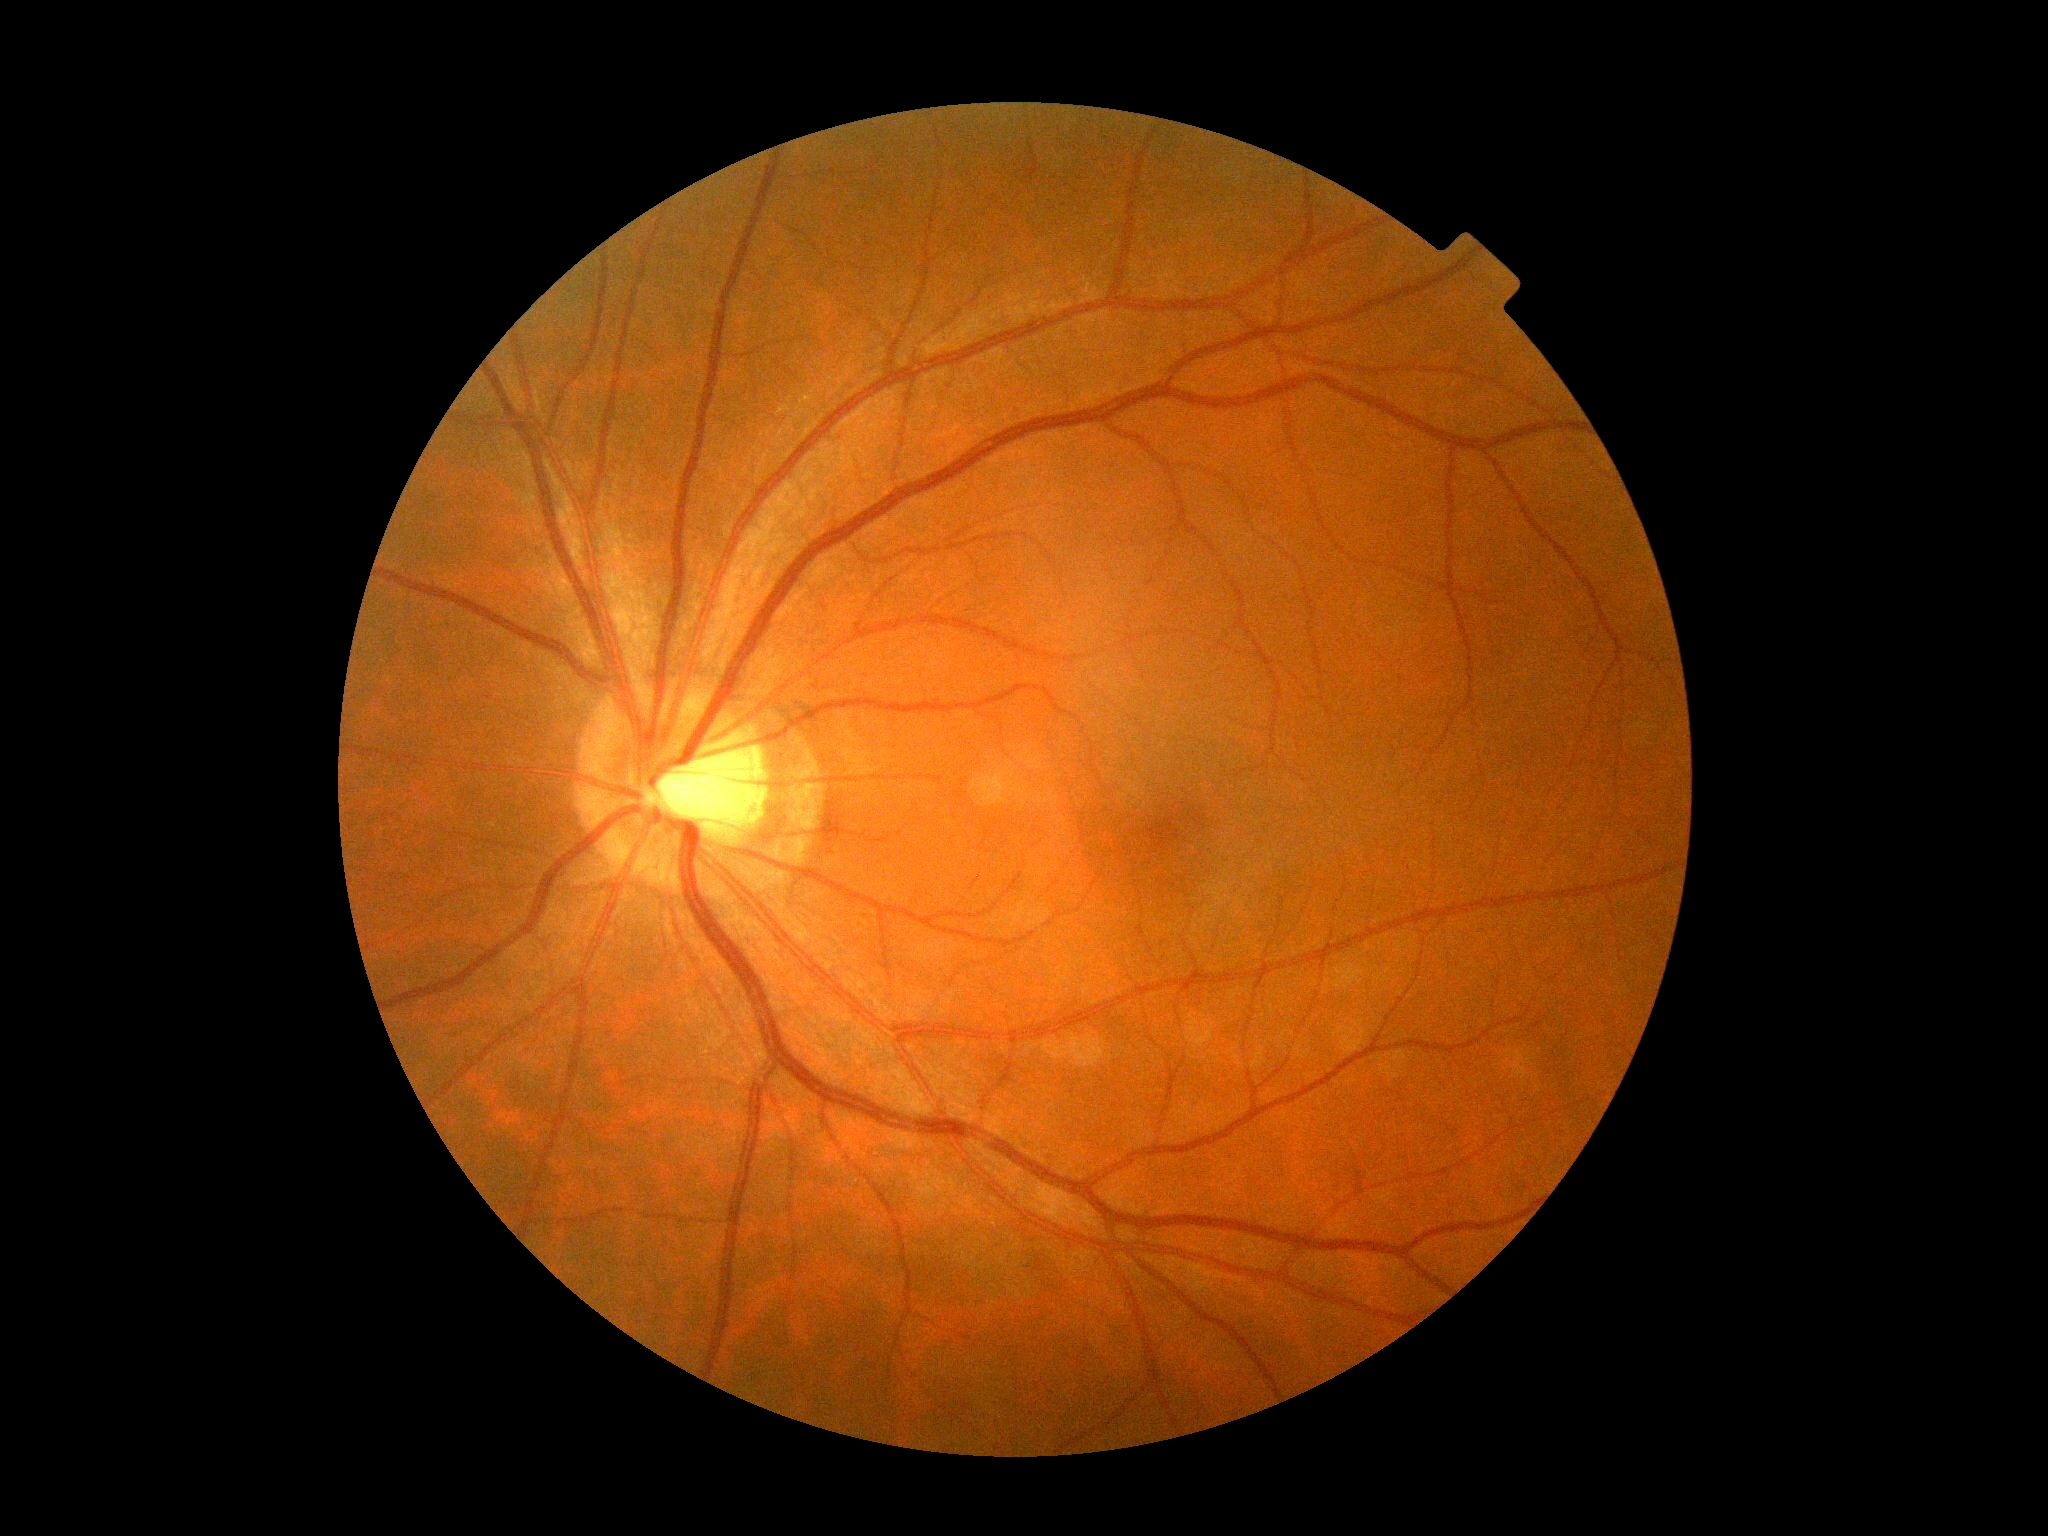
Diabetic retinopathy (DR) is 0/4 — no visible signs of diabetic retinopathy.